Infant wide-field fundus photograph
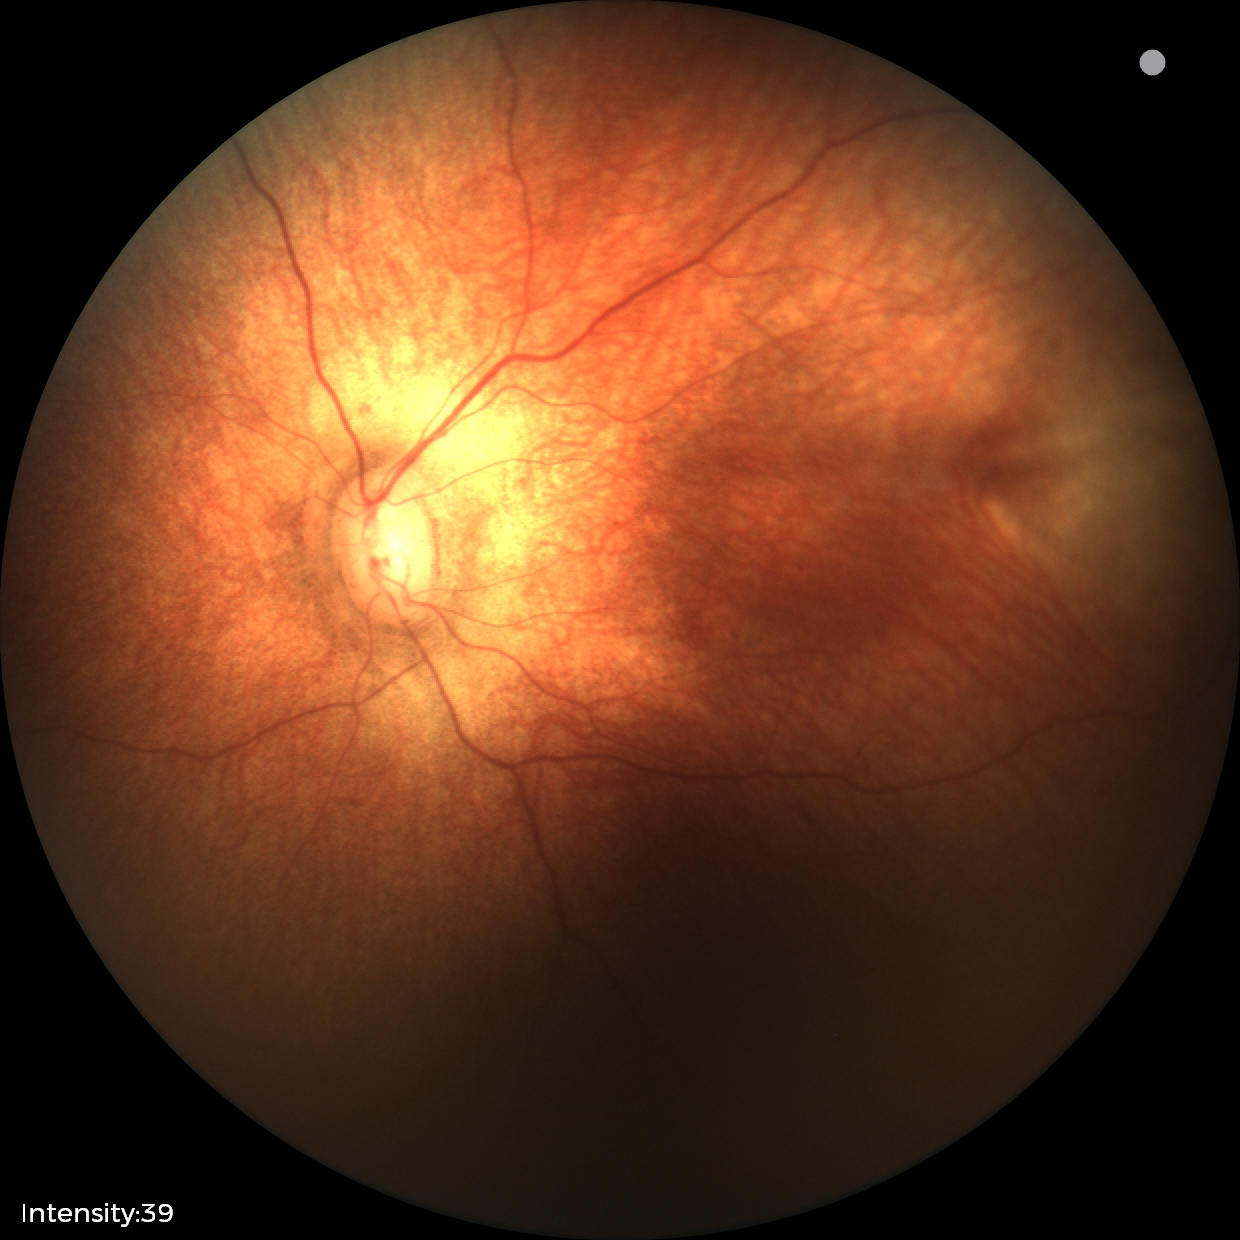 Normal screening examination.